NIDEK AFC-230 fundus camera · 45 degree fundus photograph · modified Davis classification — 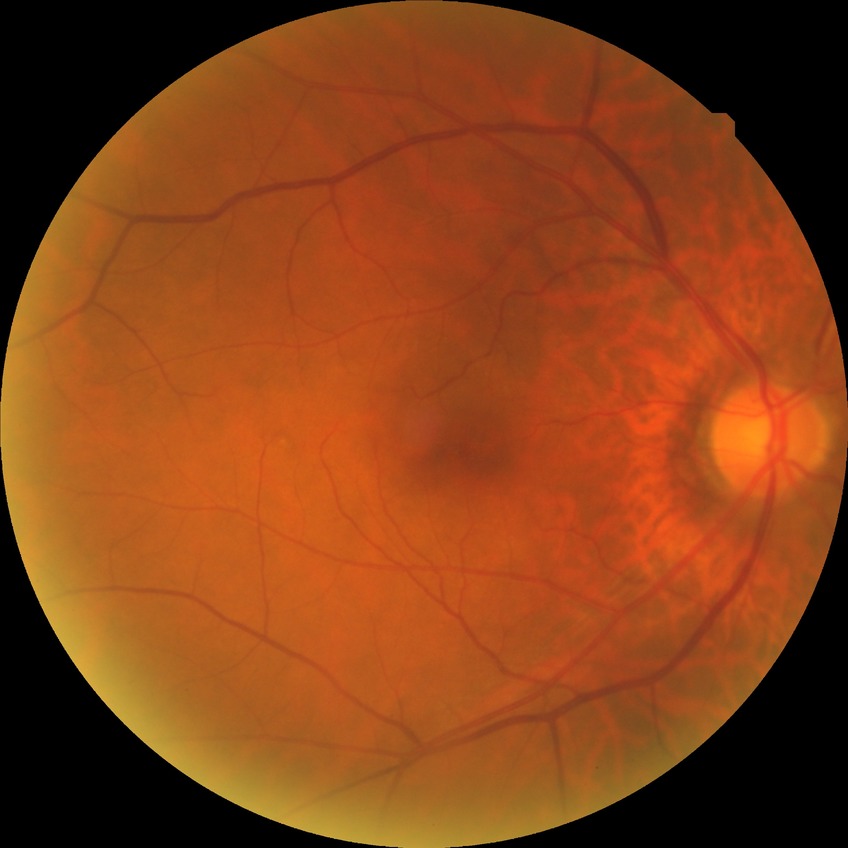
* modified Davis classification: no diabetic retinopathy